Disc-centered fundus crop.
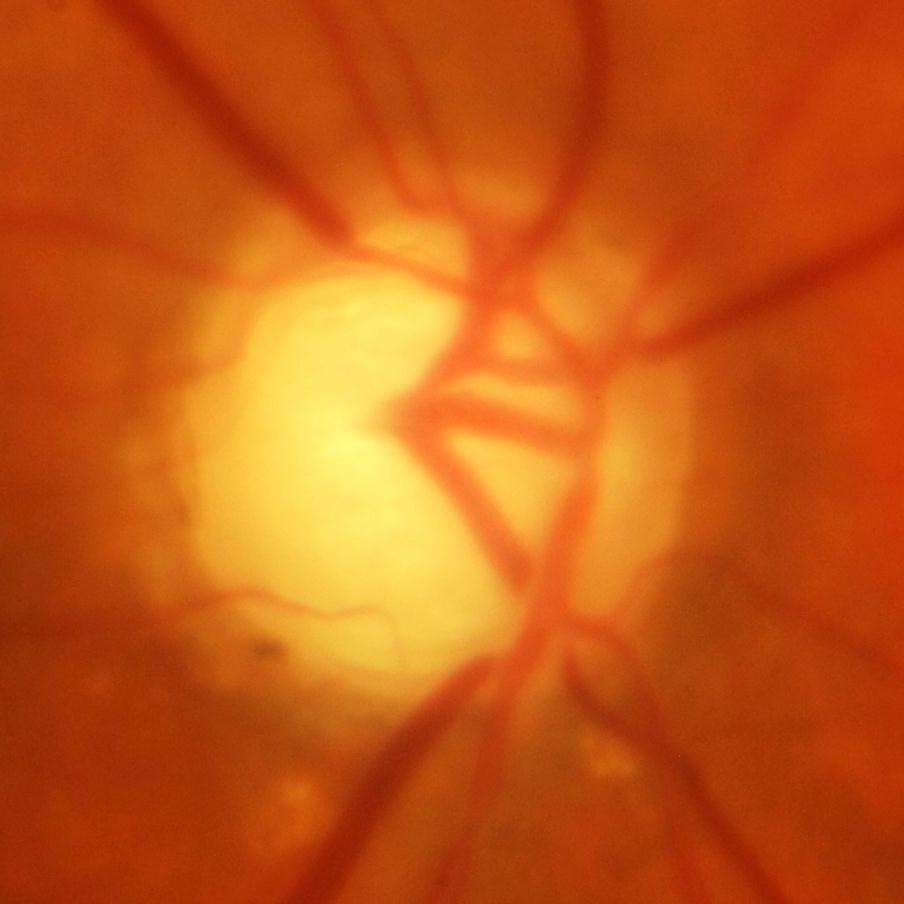
Q: Is there glaucomatous optic neuropathy?
A: Glaucomatous damage to the optic nerve.